Modified Davis classification; 45-degree field of view; nonmydriatic; 848x848.
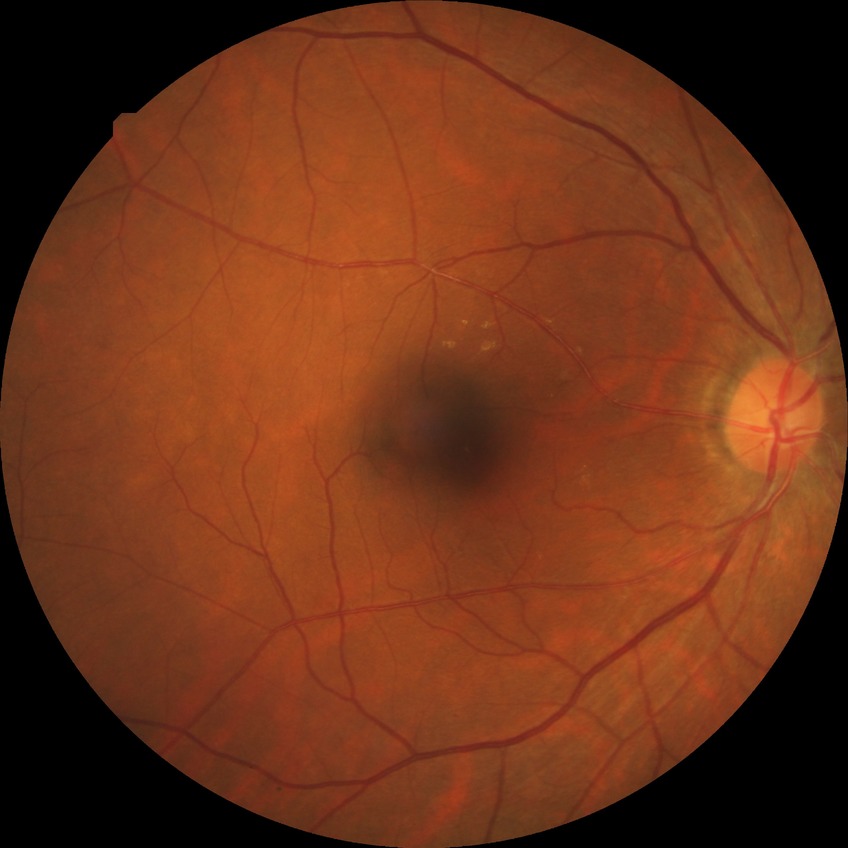
* diabetic retinopathy (DR): NDR (no diabetic retinopathy)